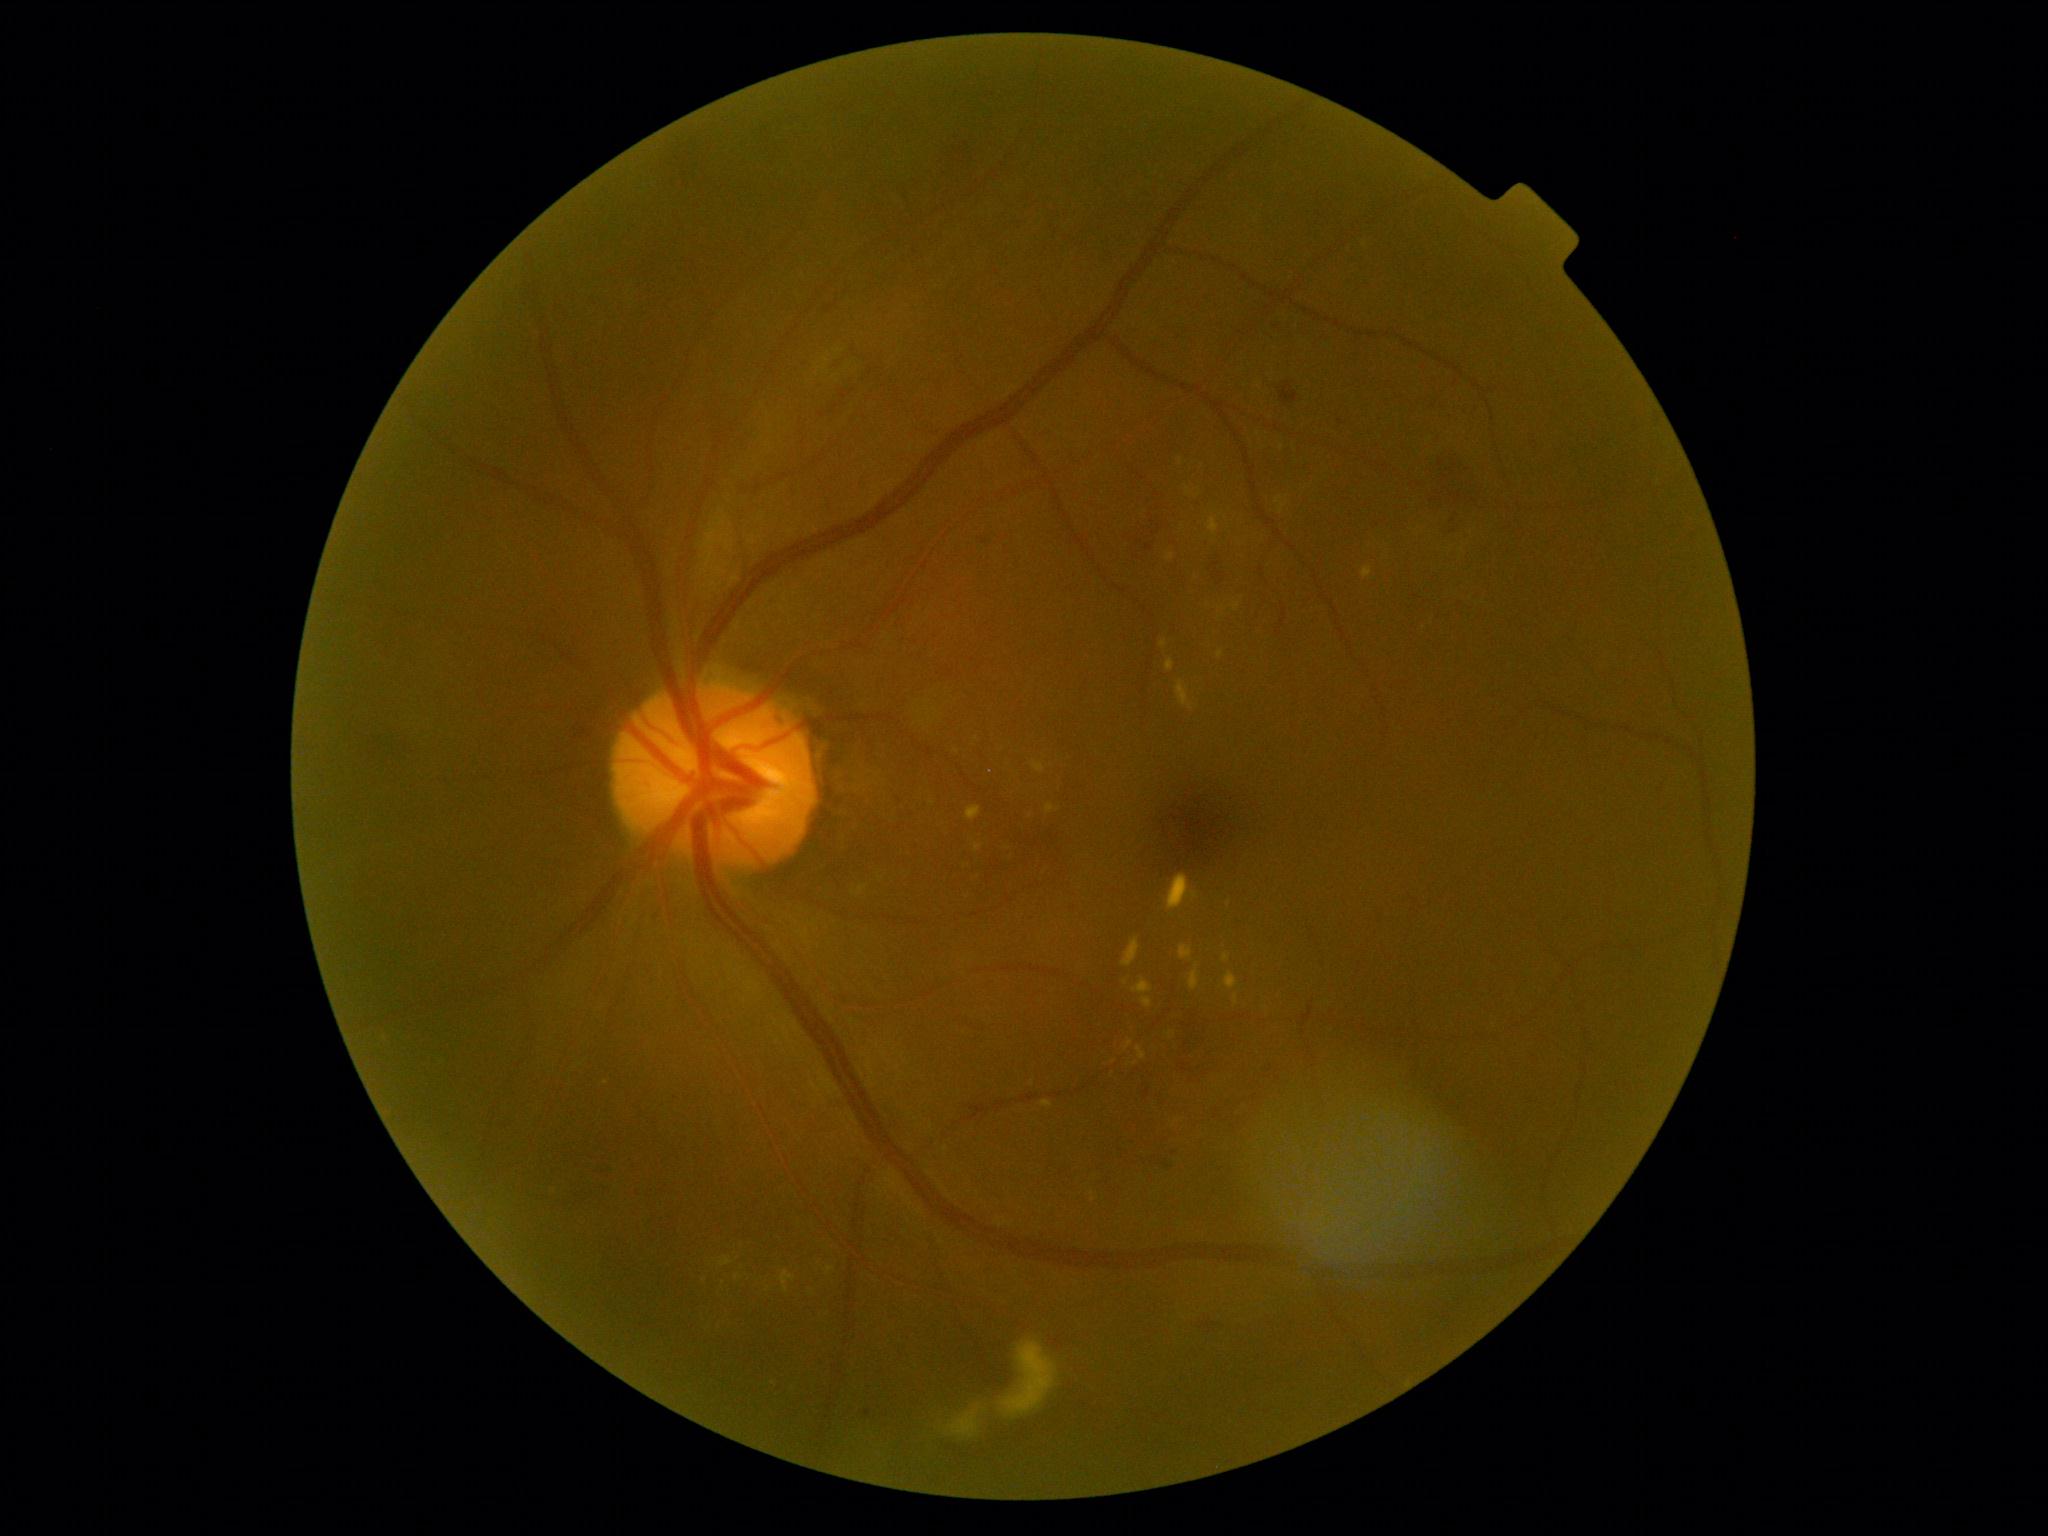
Diabetic retinopathy (DR) is grade 2 — more than just microaneurysms but less than severe NPDR.